Remidio Fundus on Phone · 1659x2212.
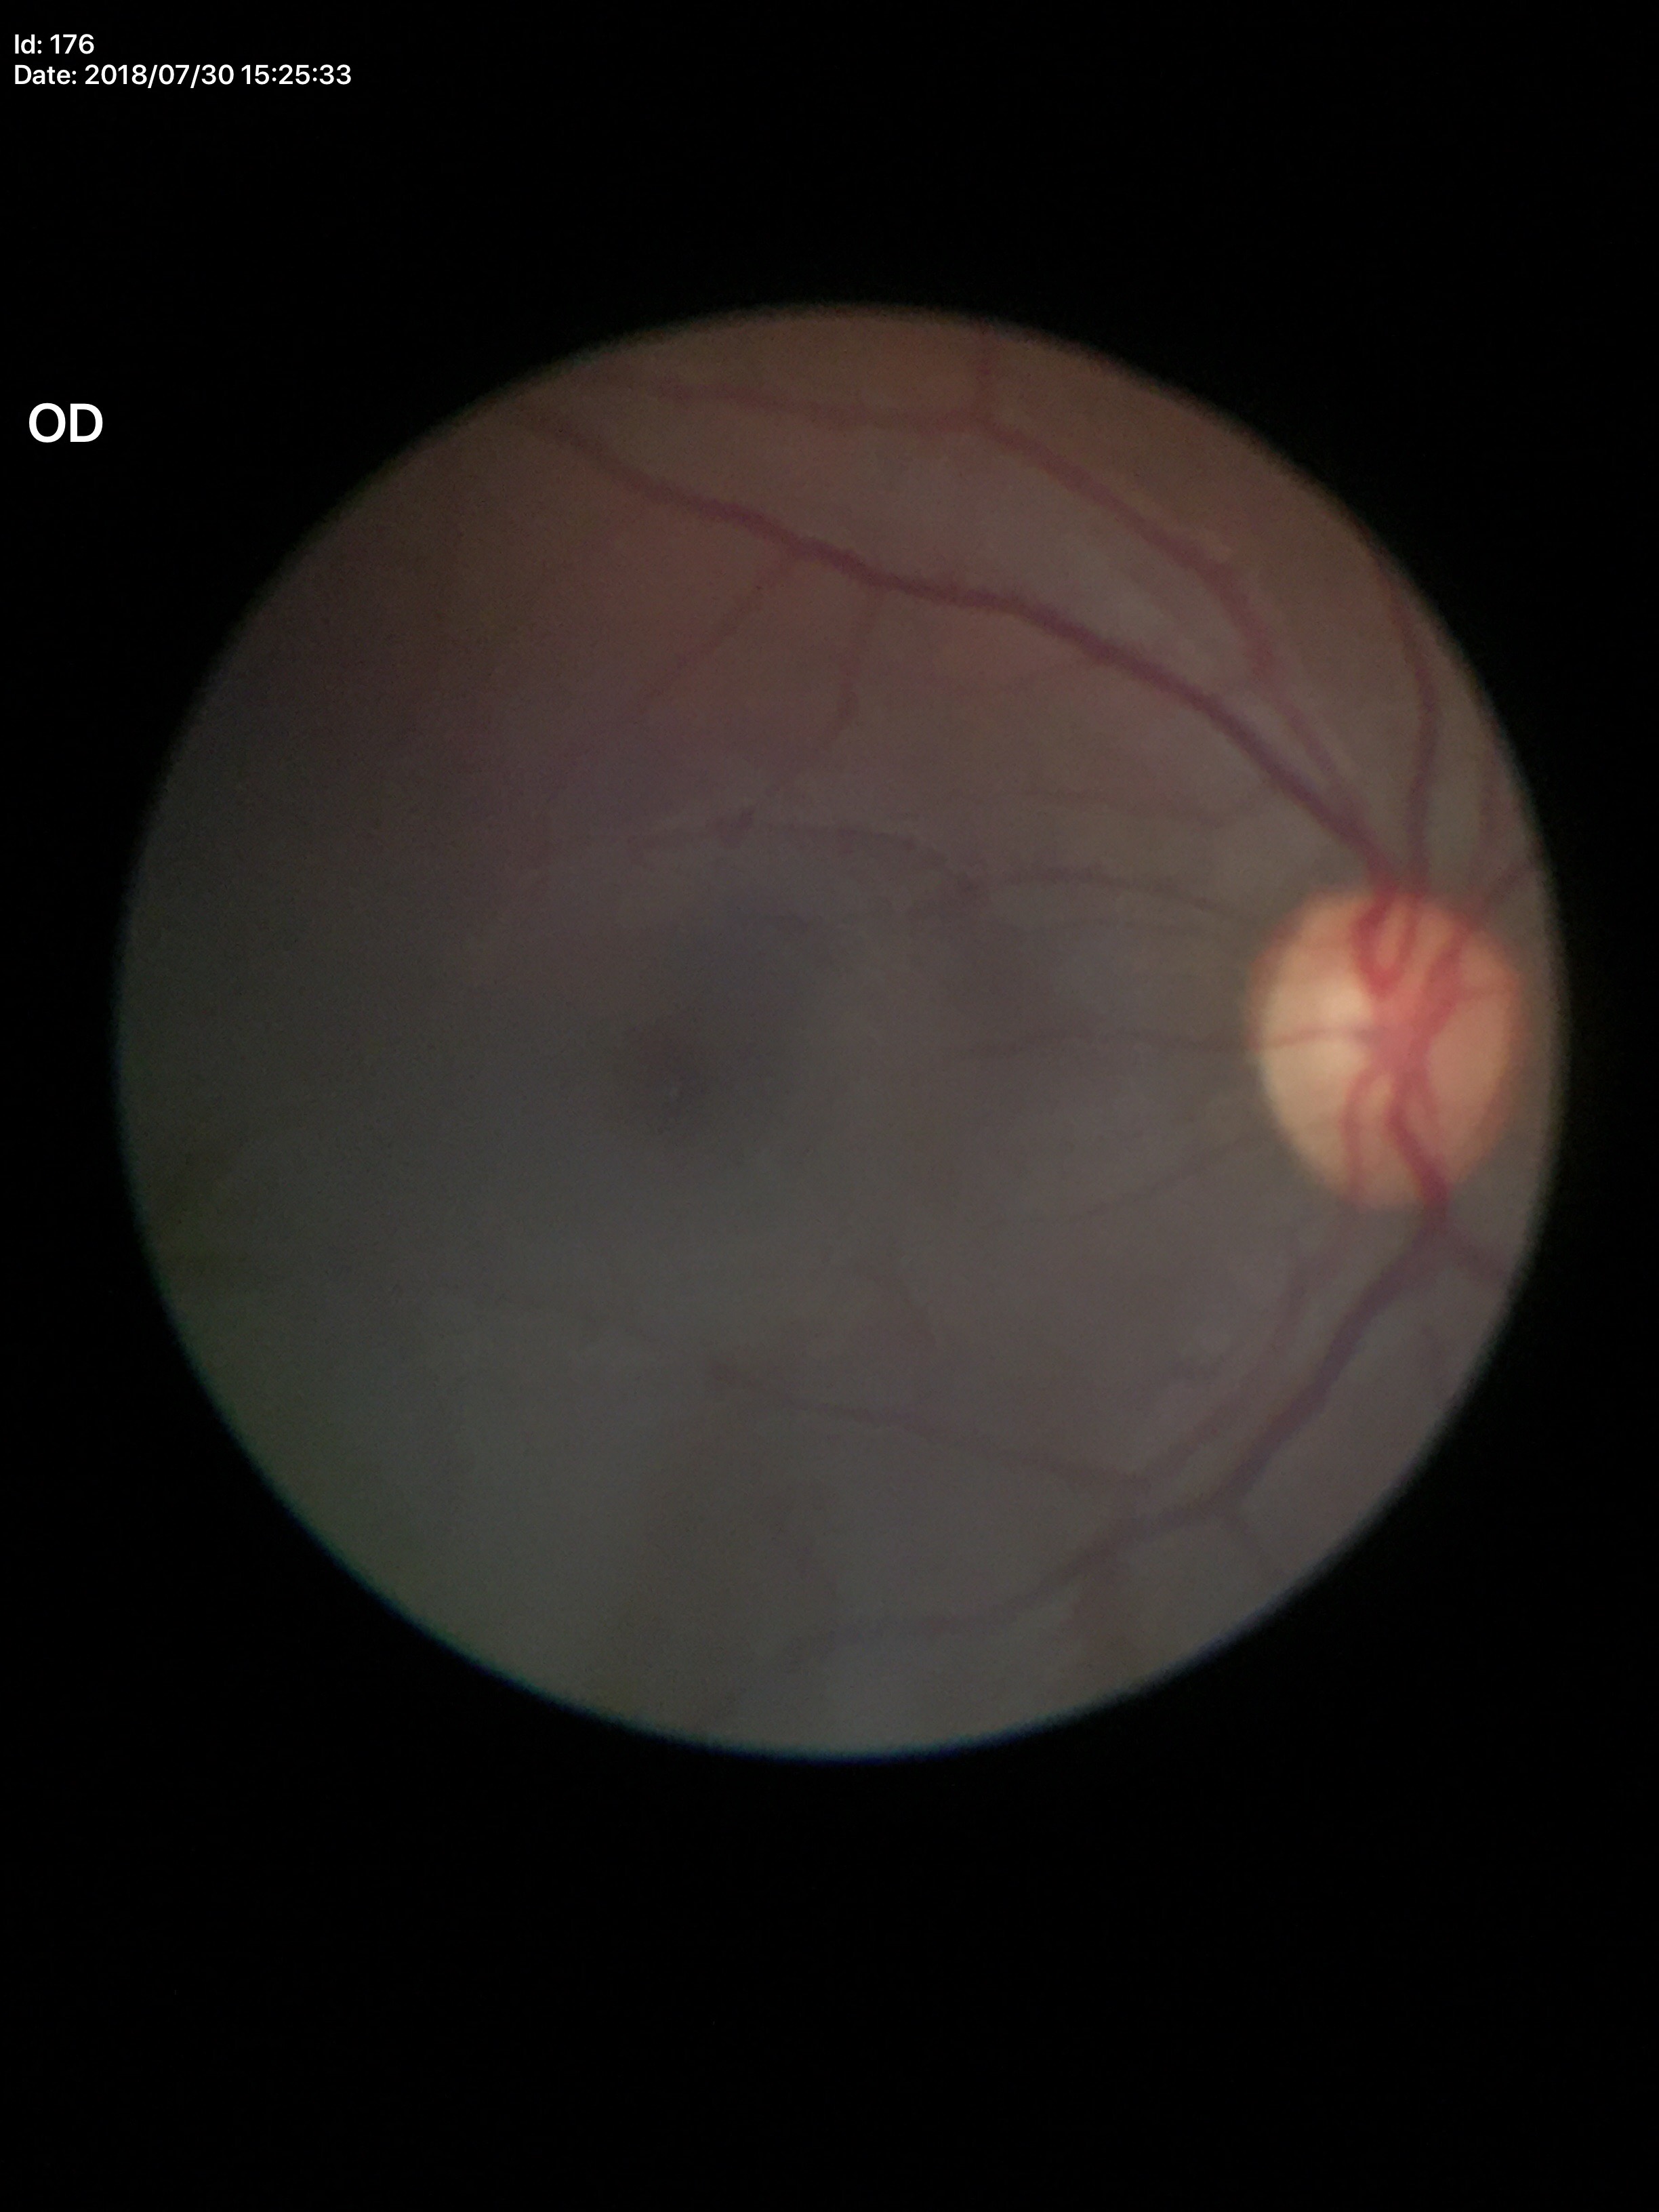
Glaucoma decision: suspicious findings (three of five ophthalmologists flagged glaucoma suspect)
vertical C/D ratio: 0.55
horizontal C/D ratio: 0.51